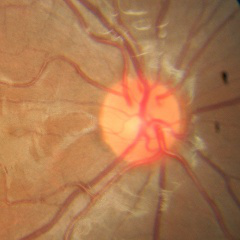
Q: What is the glaucoma diagnosis?
A: No — no glaucoma.